Fundus photo, 45-degree field of view — 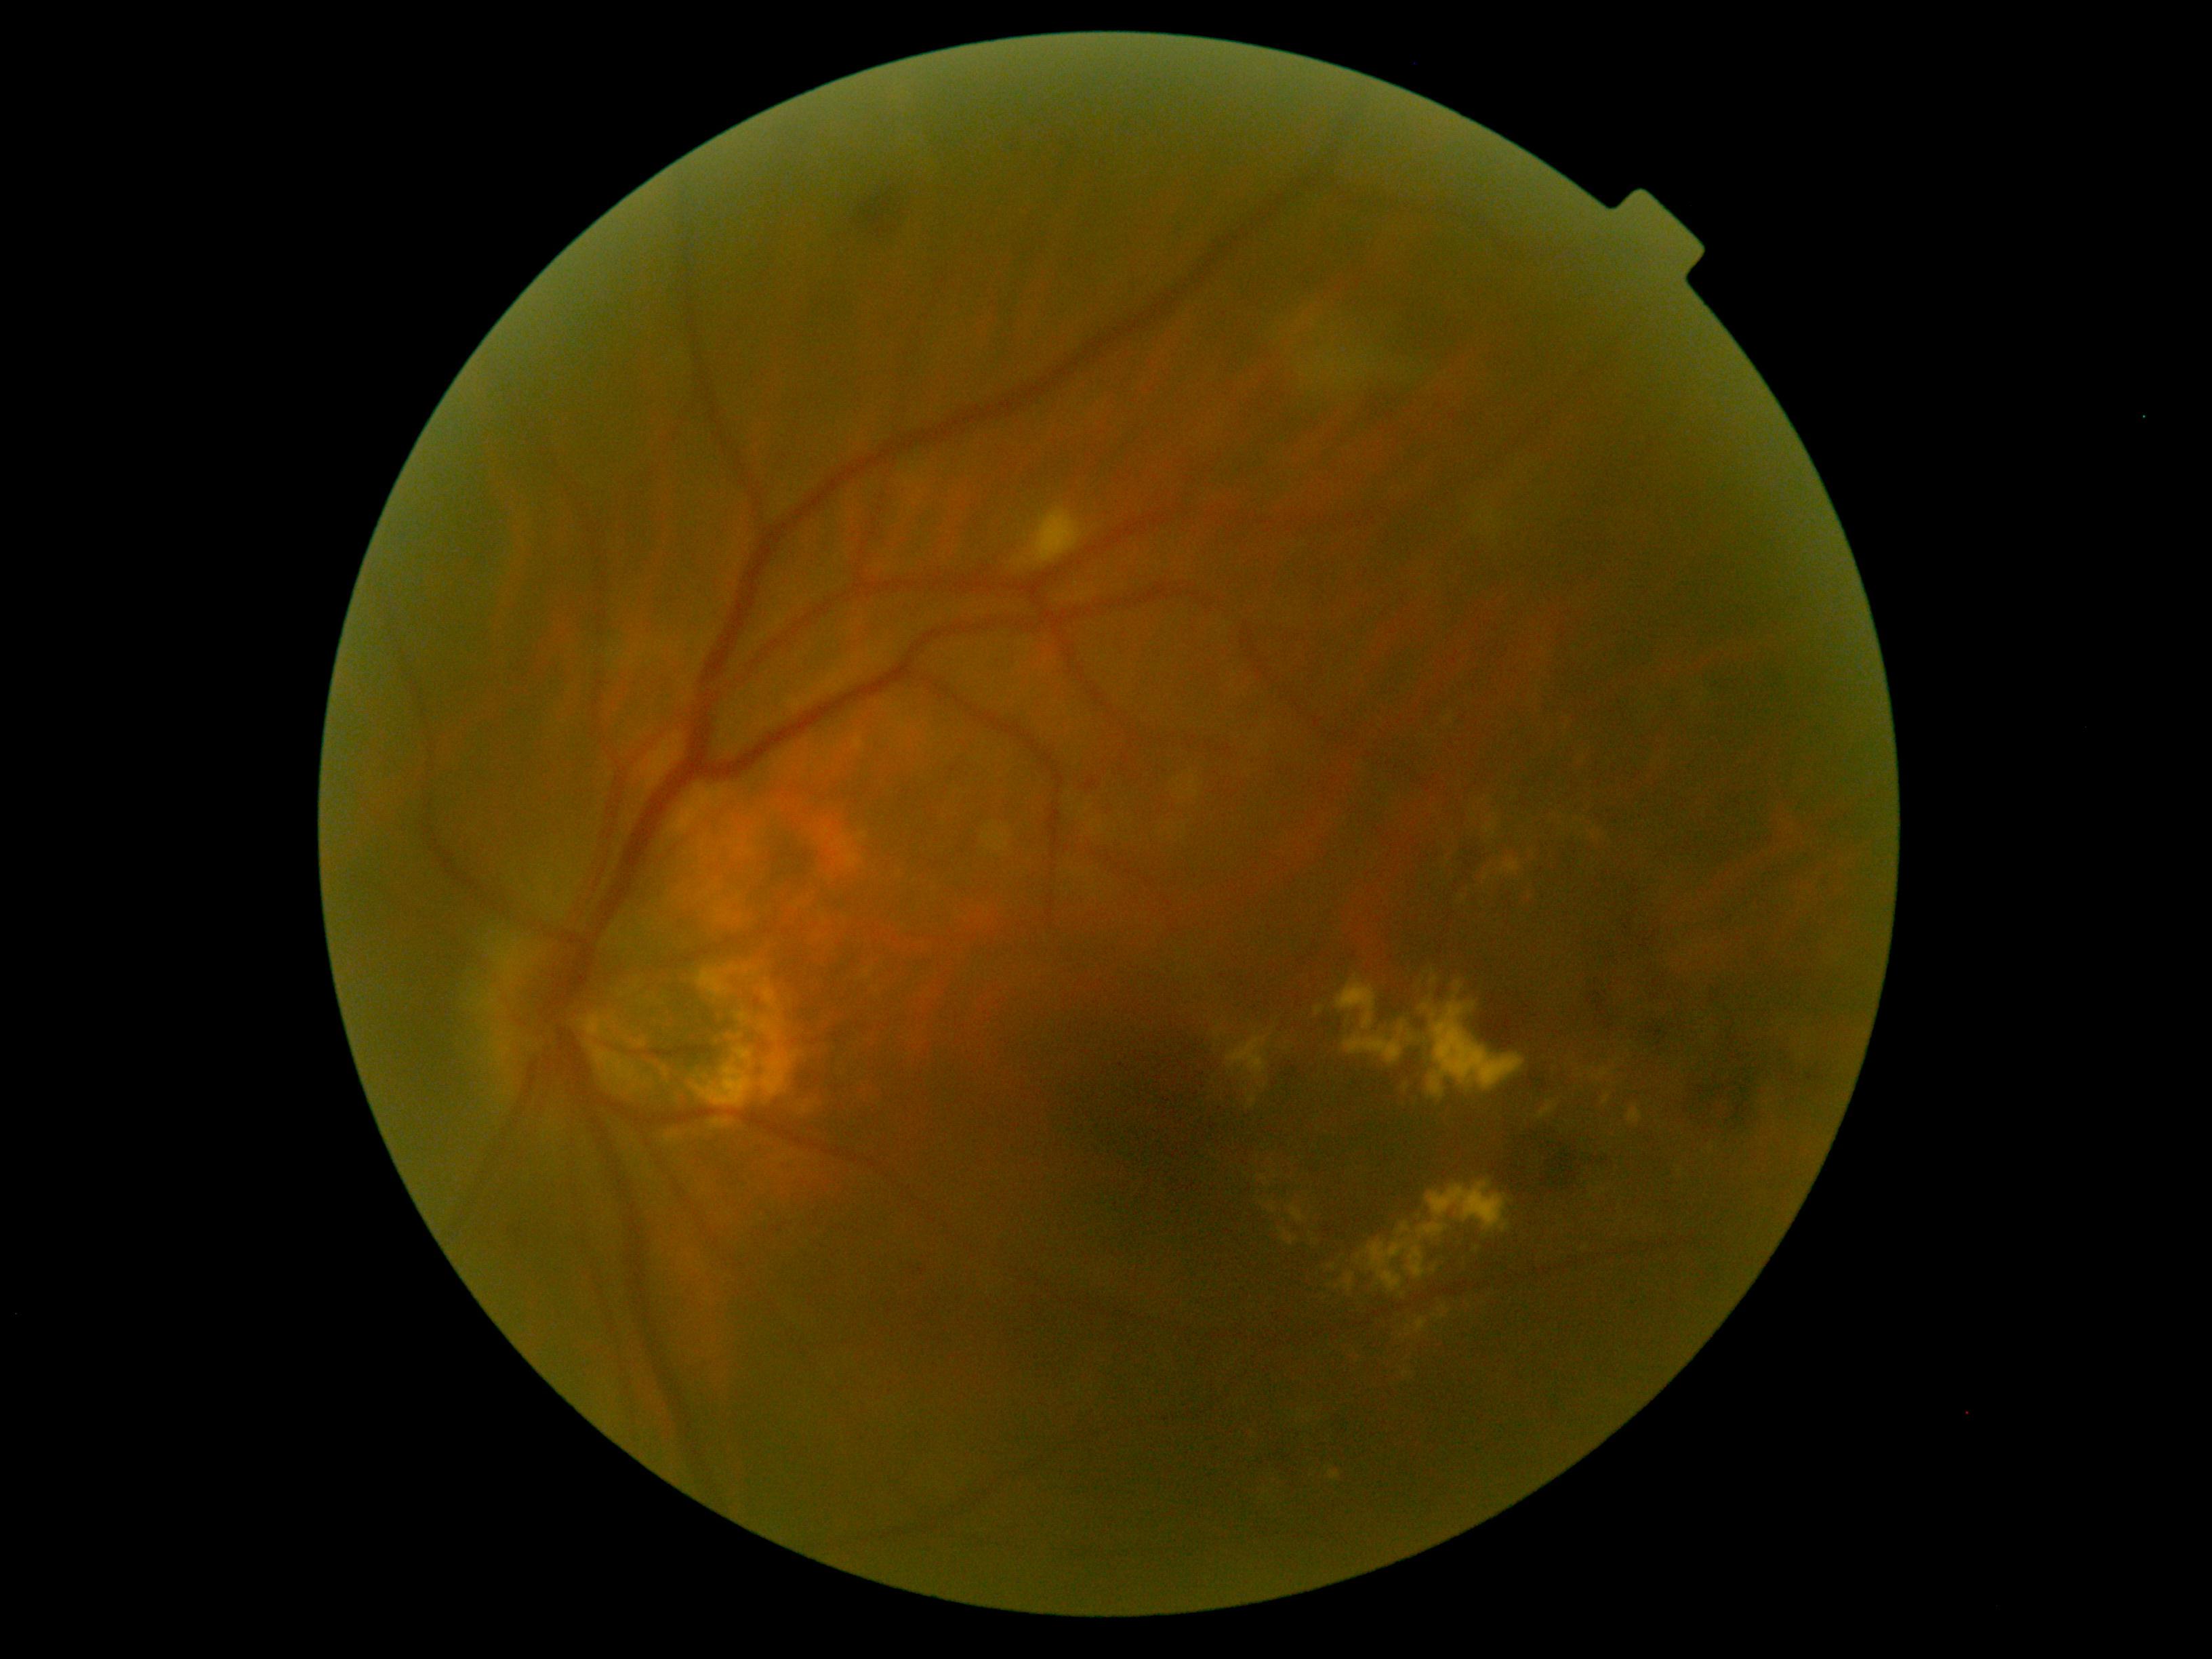

DR stage is grade 2 (moderate NPDR). The retinopathy is classified as non-proliferative diabetic retinopathy.